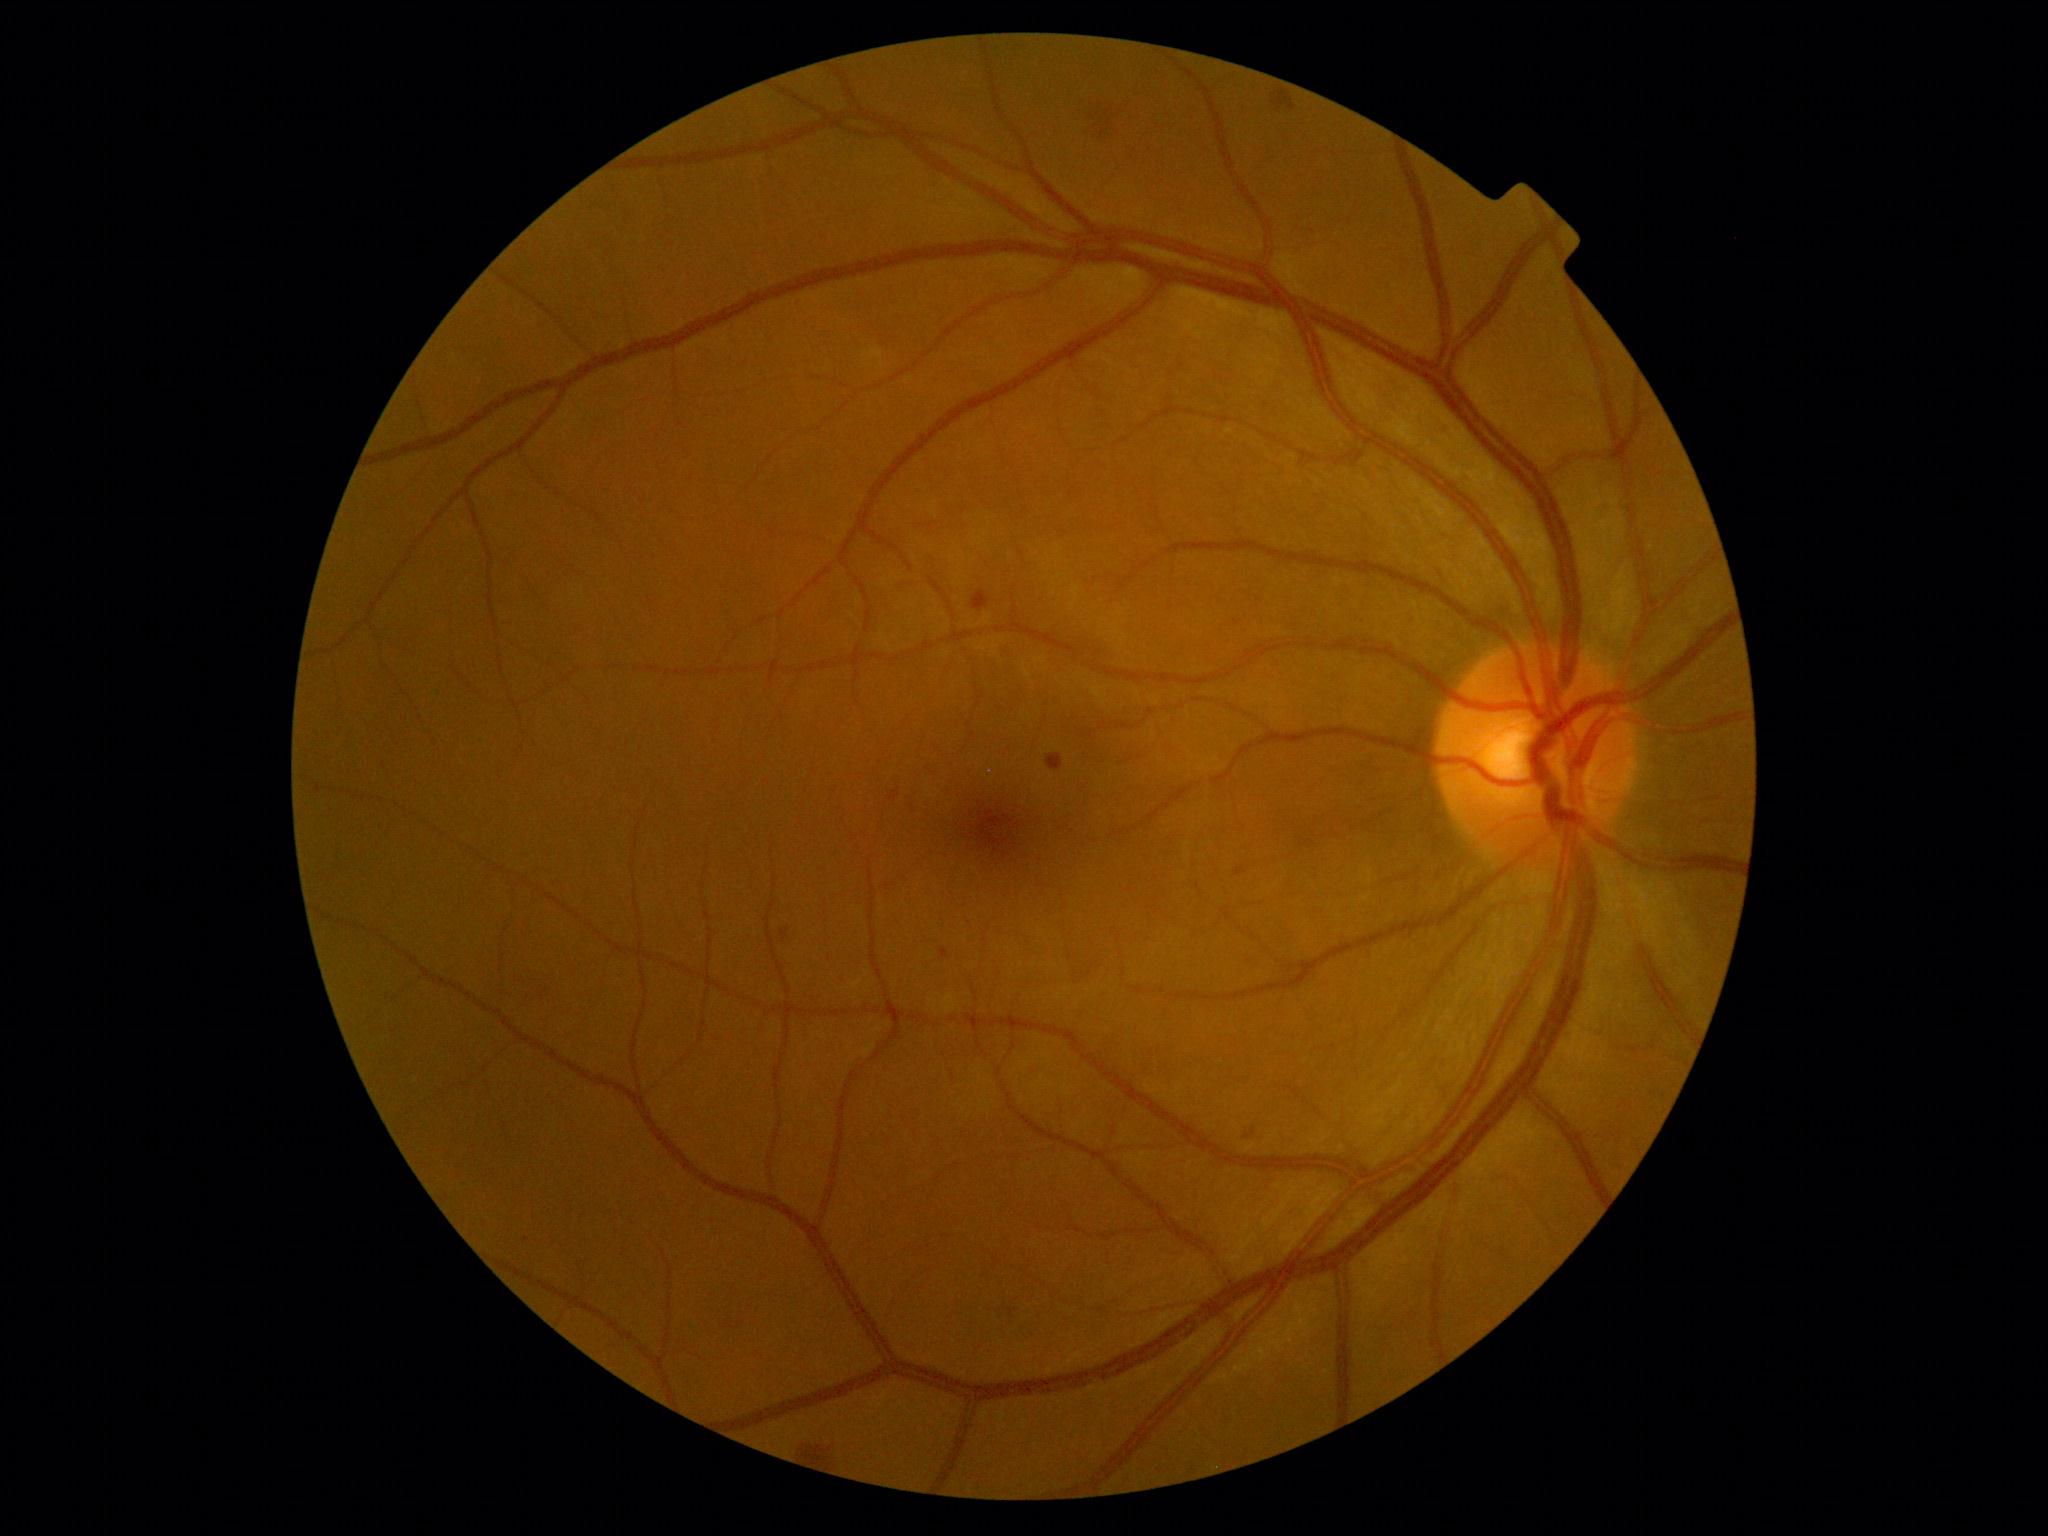
{"dr_grade": 2, "dr_grade_name": "moderate NPDR", "lesions": {"ma": [[941, 948, 949, 959], [780, 928, 790, 939], [890, 789, 900, 802], [1234, 868, 1246, 876]], "ma_small": [[1253, 1132], [1248, 1136]], "se": null, "ex": null, "he": [[1273, 90, 1296, 112], [802, 1443, 833, 1465], [1091, 113, 1114, 135], [1047, 755, 1064, 772], [972, 591, 991, 613]]}}